Camera: Topcon TRC-NW8.
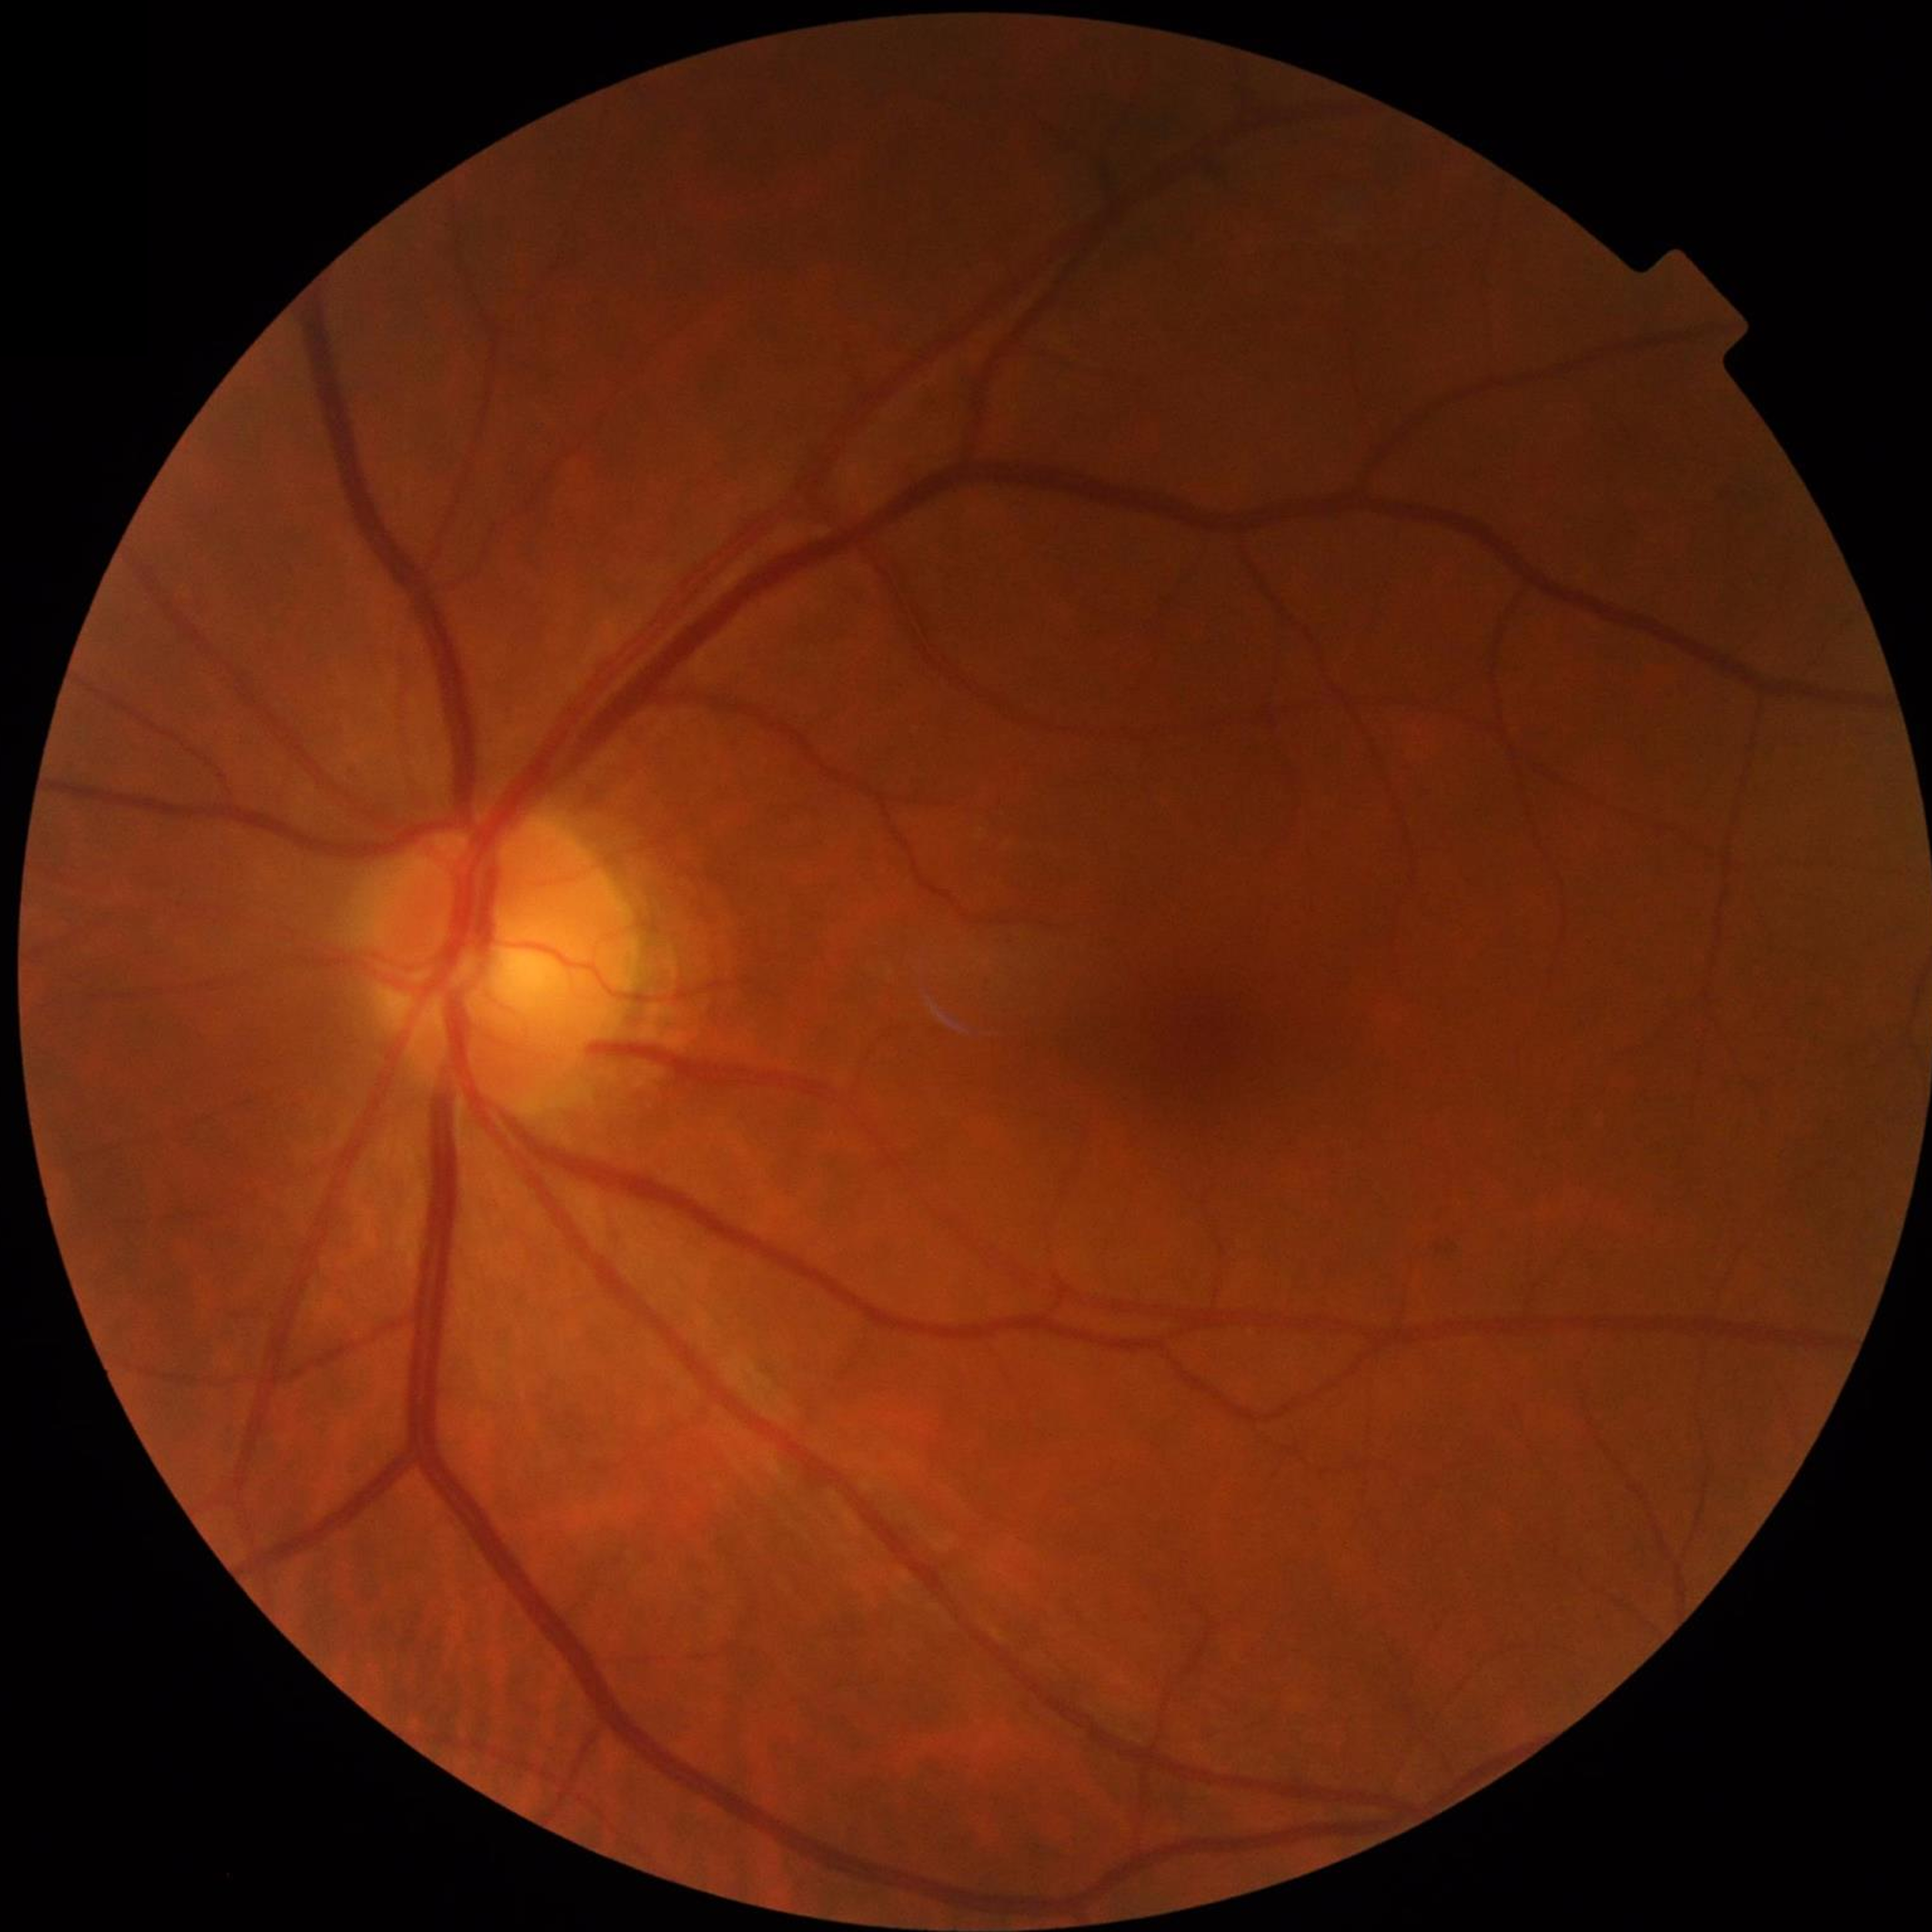
No AMD, DR, or glaucomatous findings. Quality: good.